Acquired on the Natus RetCam Envision; 1440x1080; wide-field contact fundus photograph of an infant: 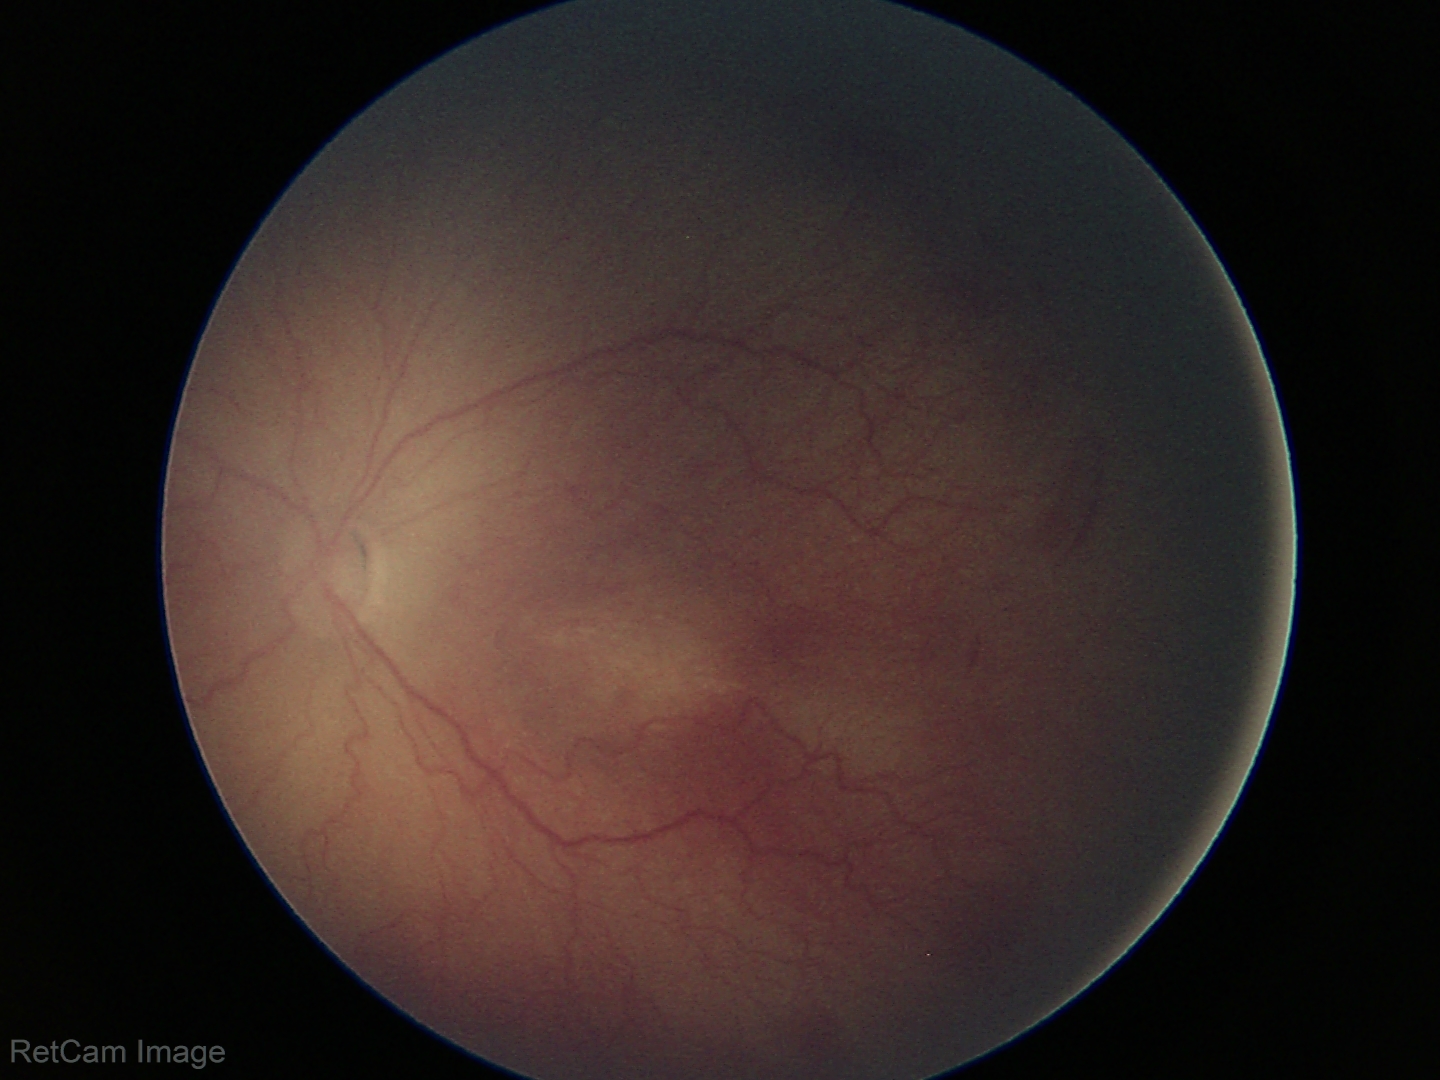

Screening diagnosis: retinopathy of prematurity stage 2.